Tabletop color fundus camera image.
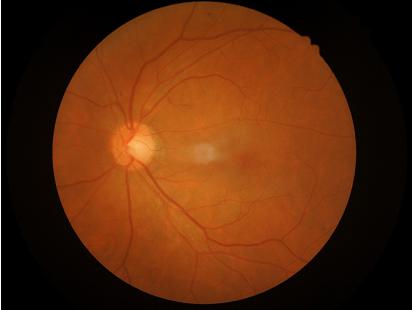 Image is sharp throughout the field. Overall quality is good and the image is gradable. Contrast is good.